2352x1568; fundus photo
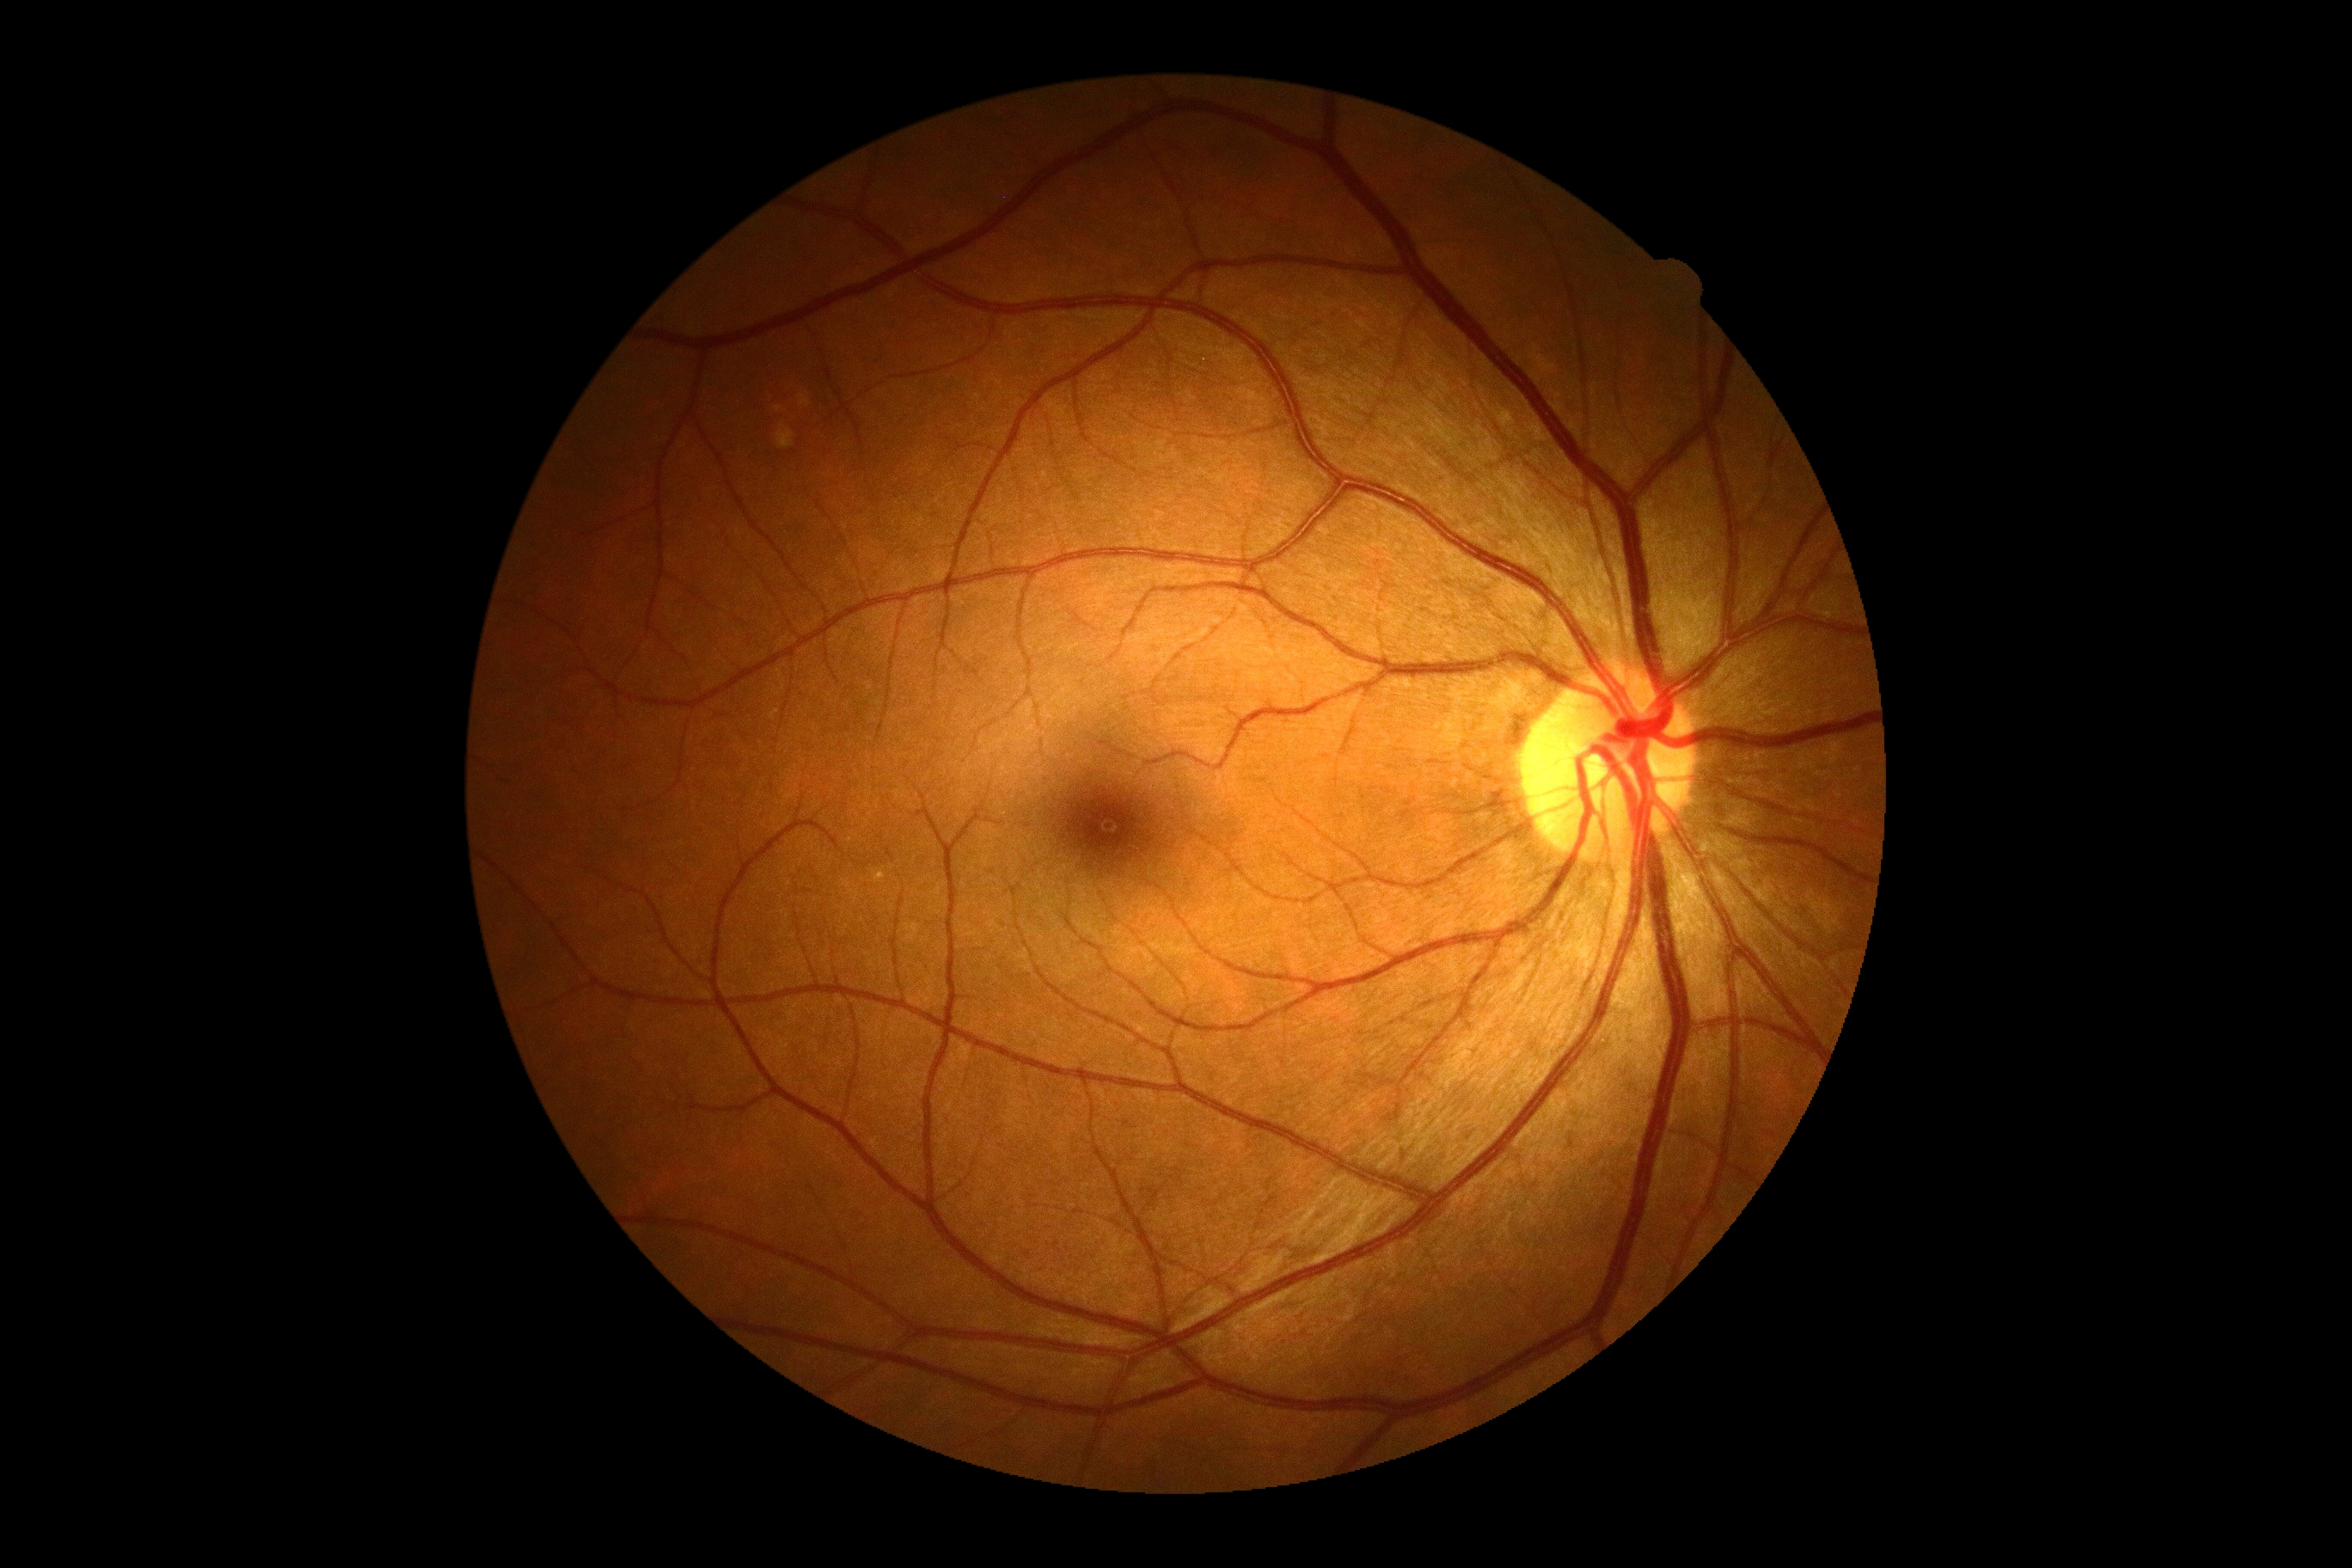

retinopathy: grade 0 (no apparent retinopathy).